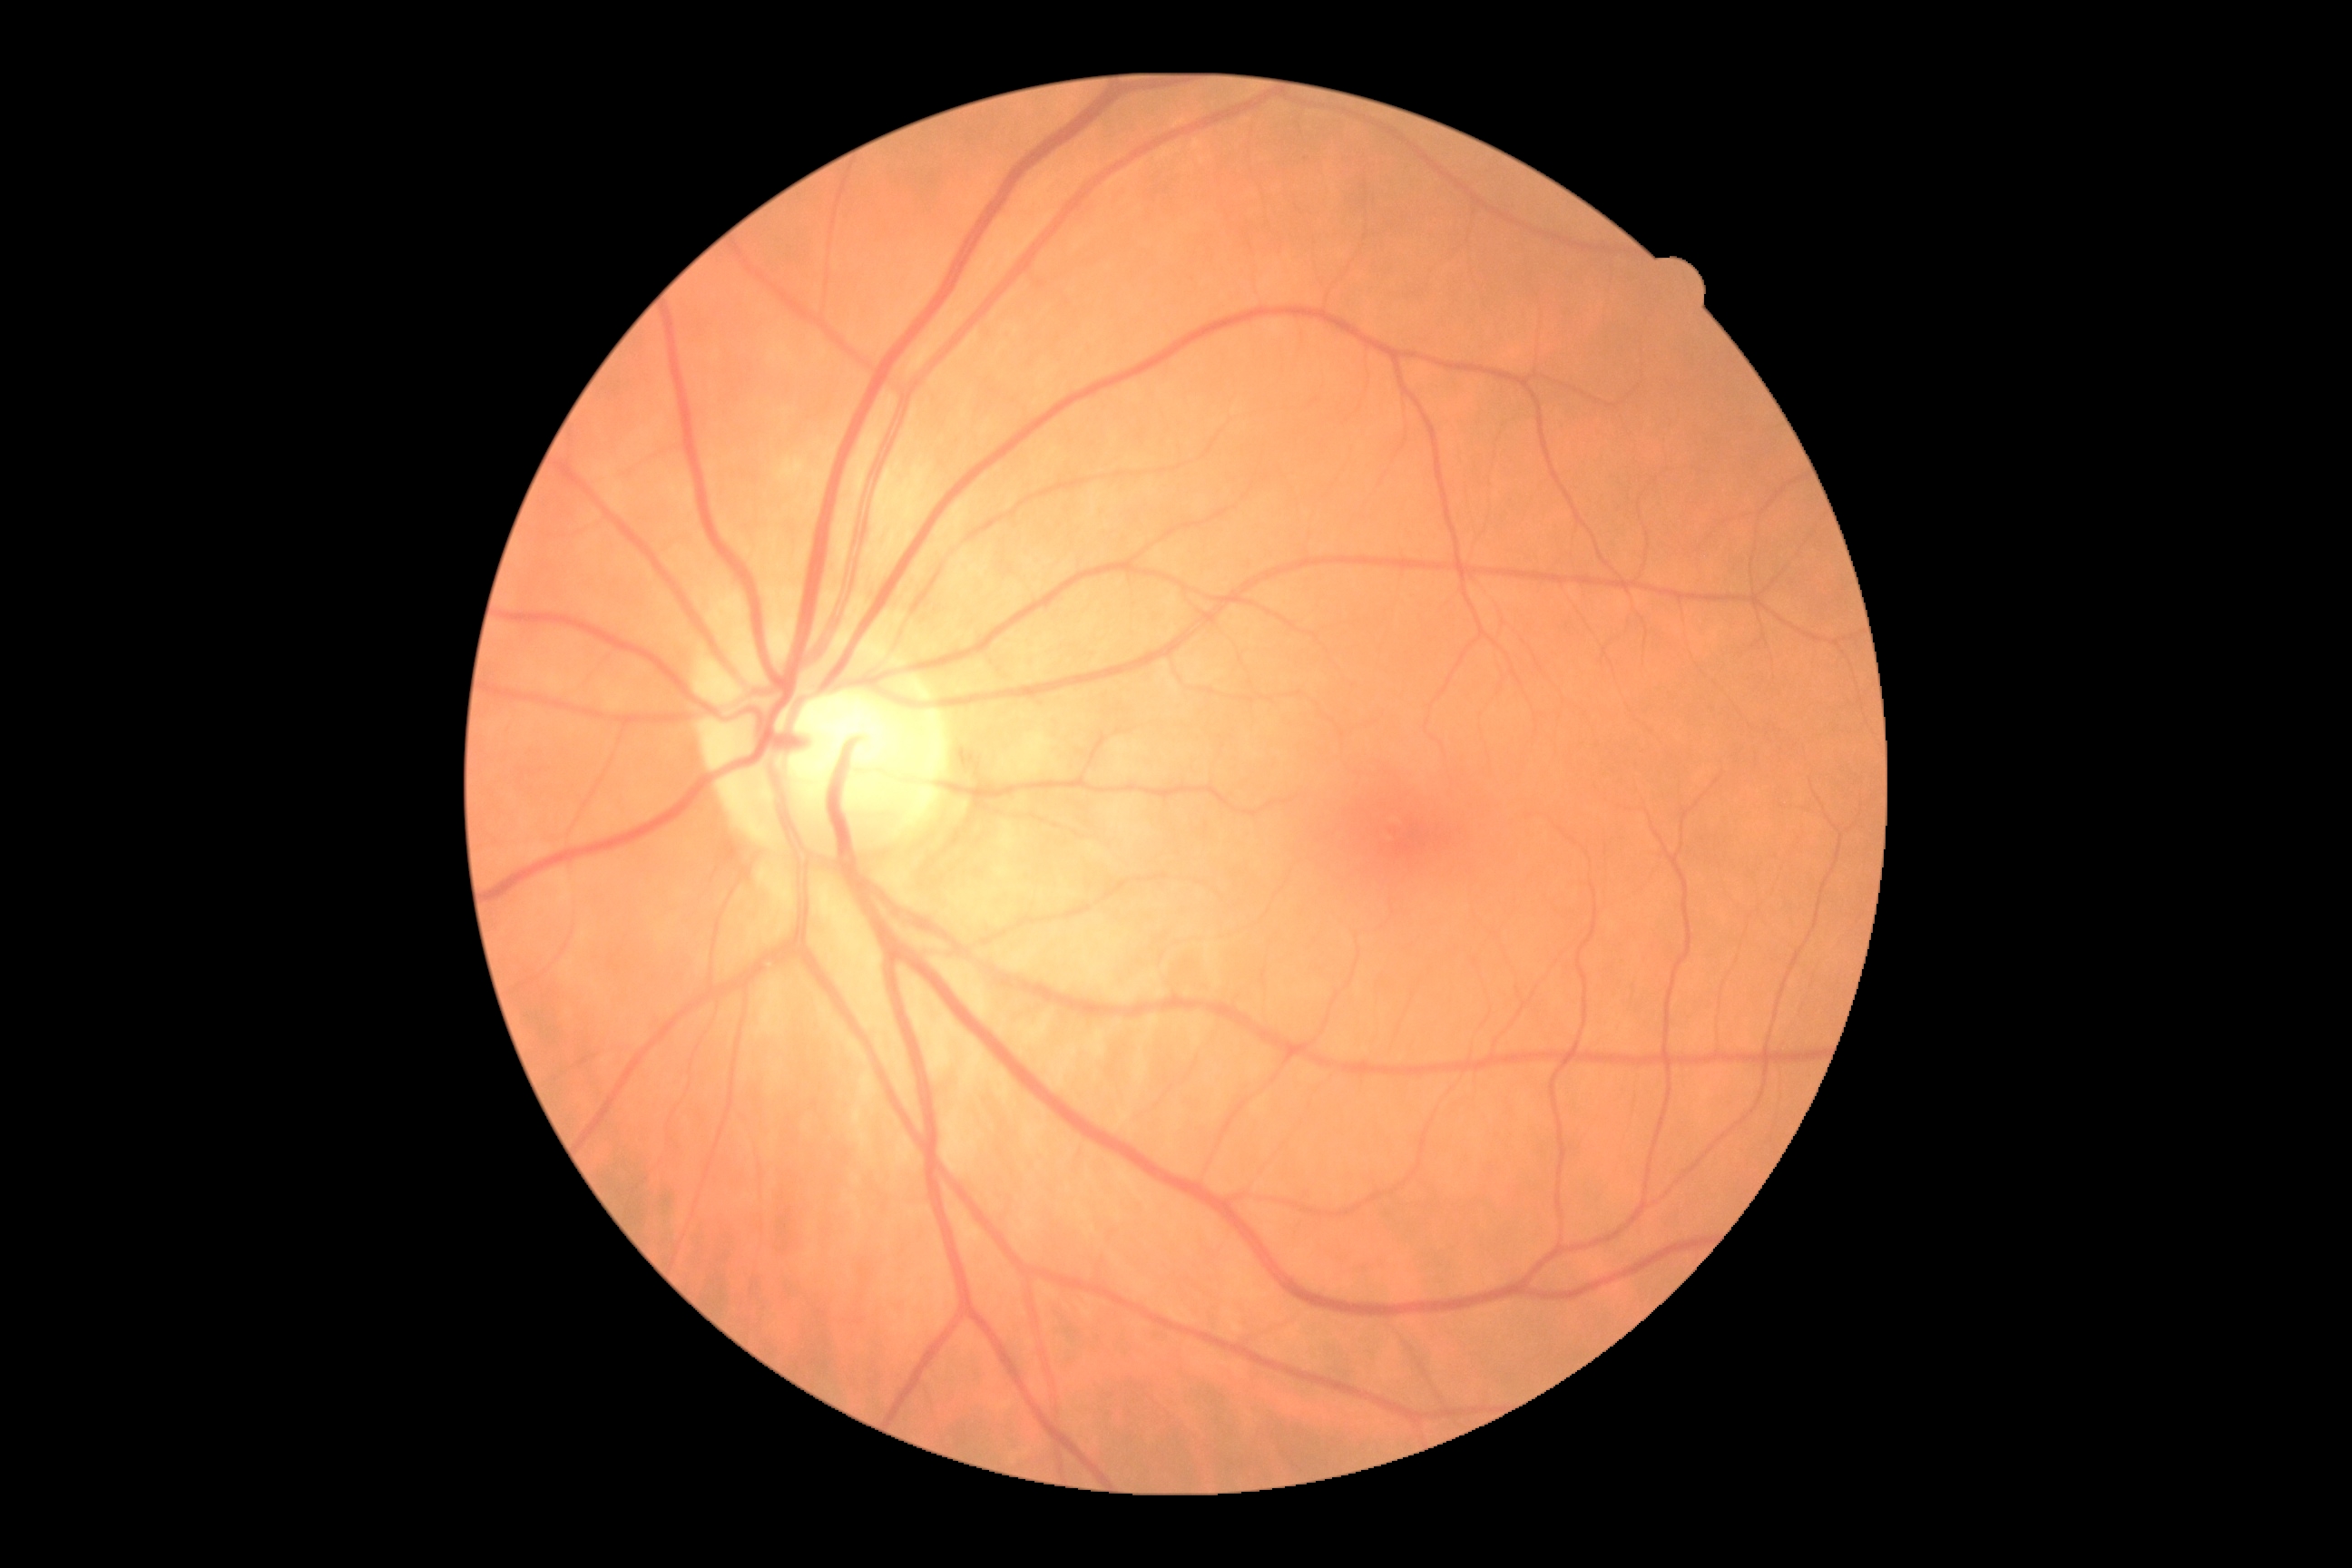

Diabetic retinopathy (DR) is 0. No diabetic retinal disease findings.